Color fundus image.
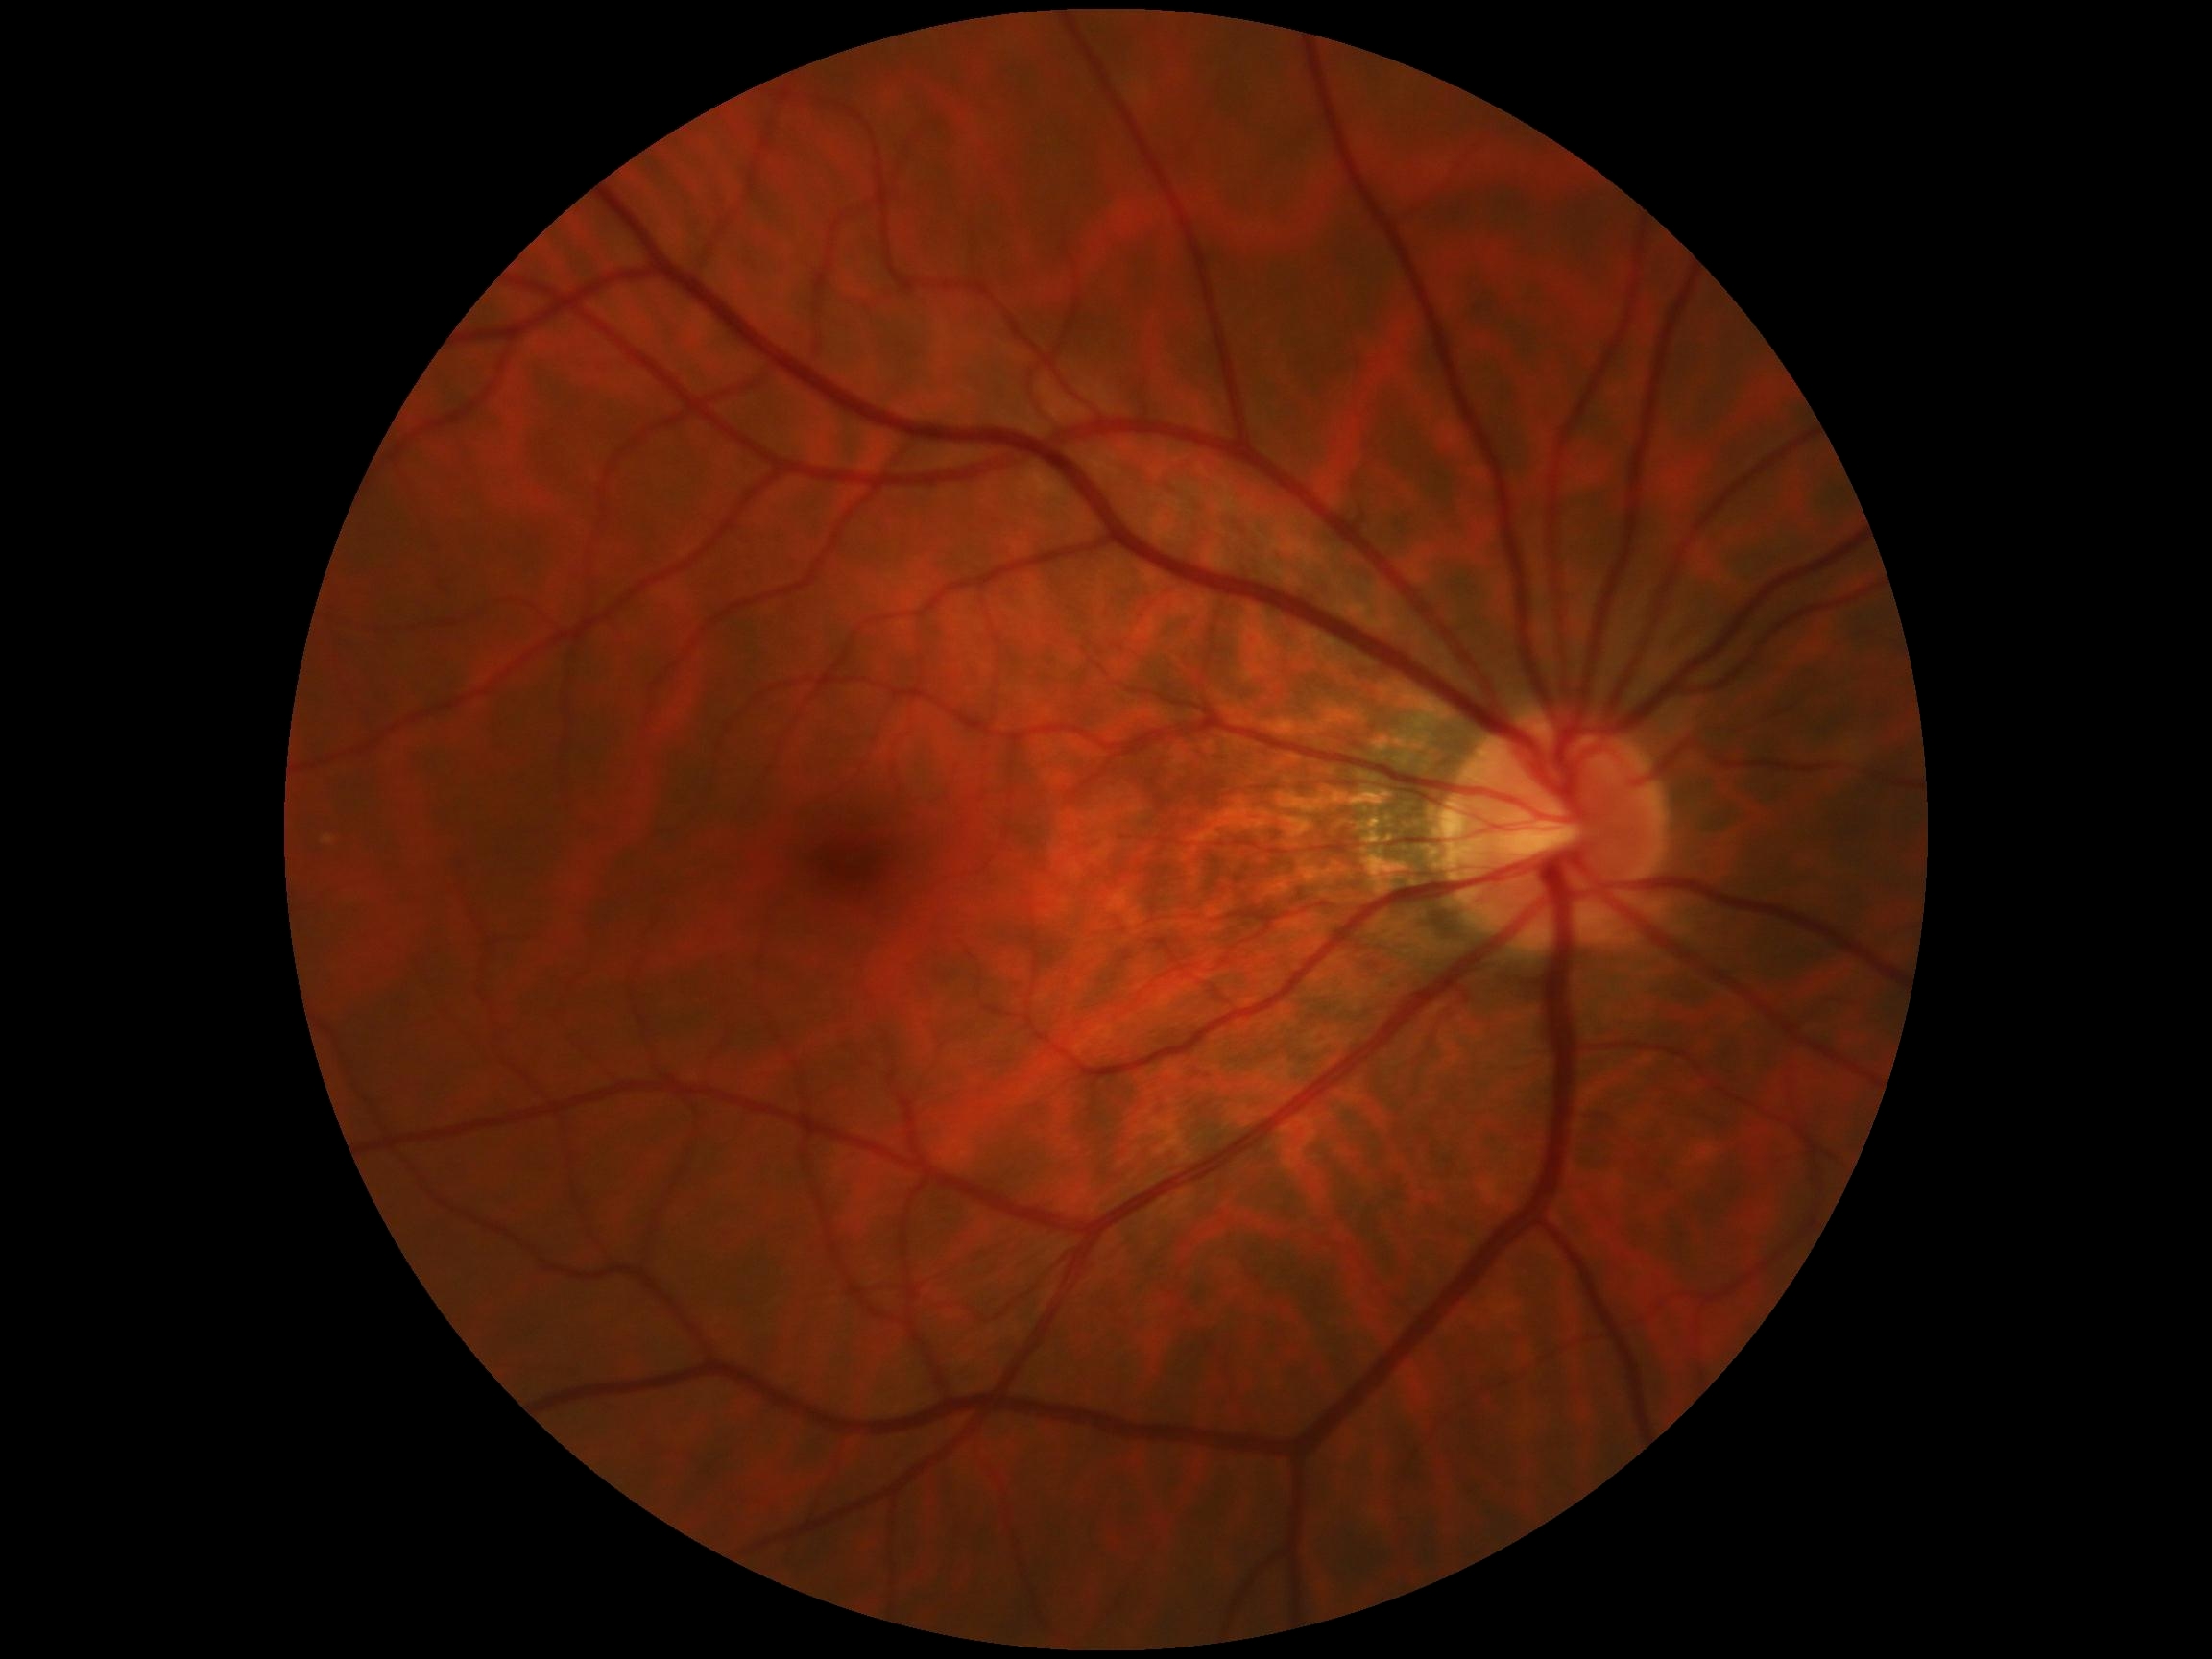

DR impression: no signs of DR, retinopathy: grade 0 (no apparent retinopathy).